1932x1932px.
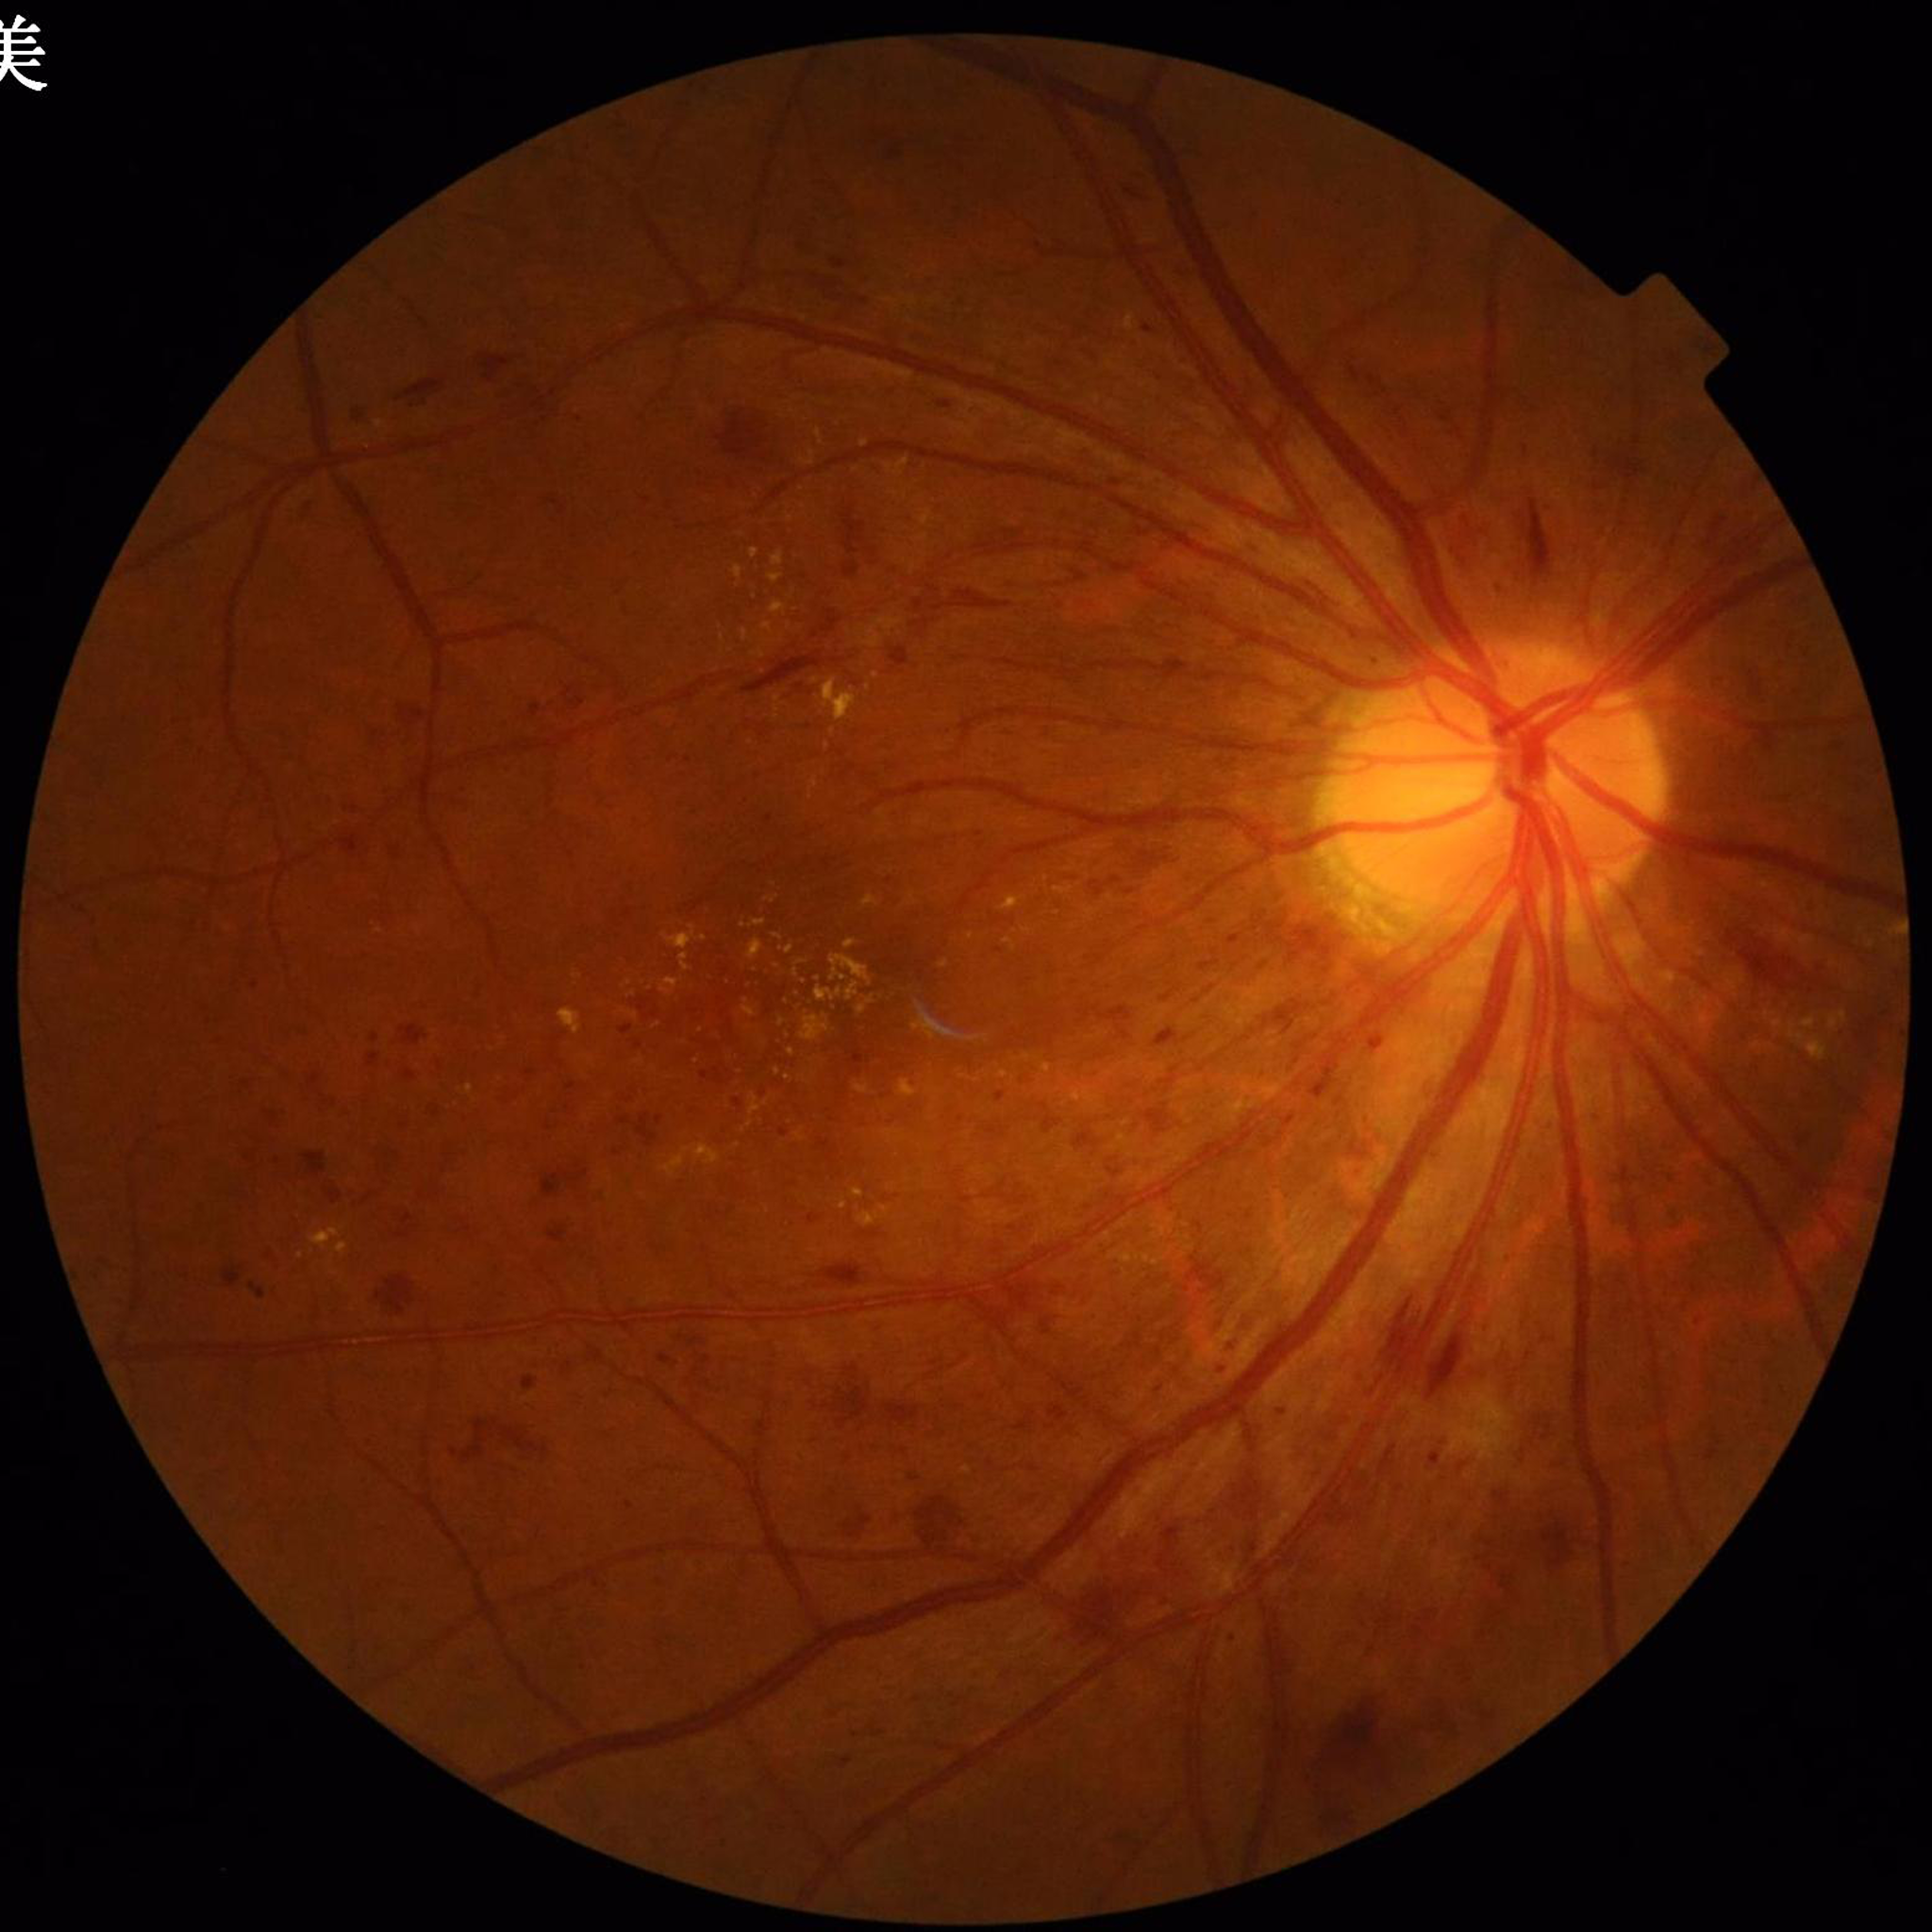

Diagnosis: DR; Photo quality: good.